Posterior pole color fundus photograph; without pupil dilation; FOV: 45 degrees: 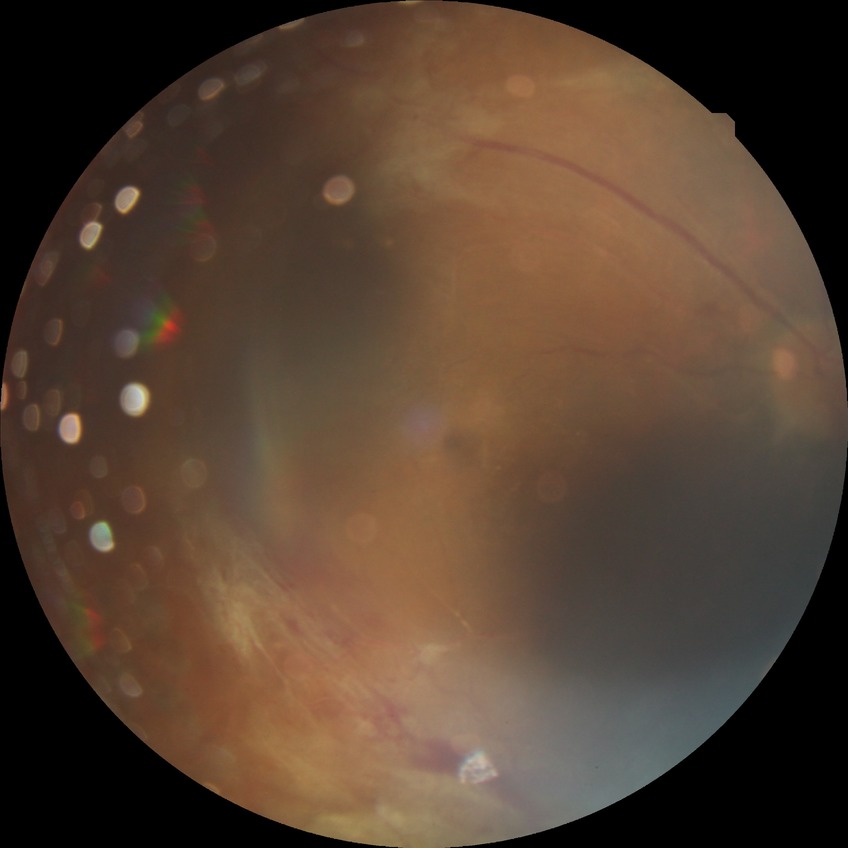
Diabetic retinopathy stage is proliferative diabetic retinopathy.